Without pupil dilation; NIDEK AFC-230; modified Davis classification; 848x848px; 45-degree field of view:
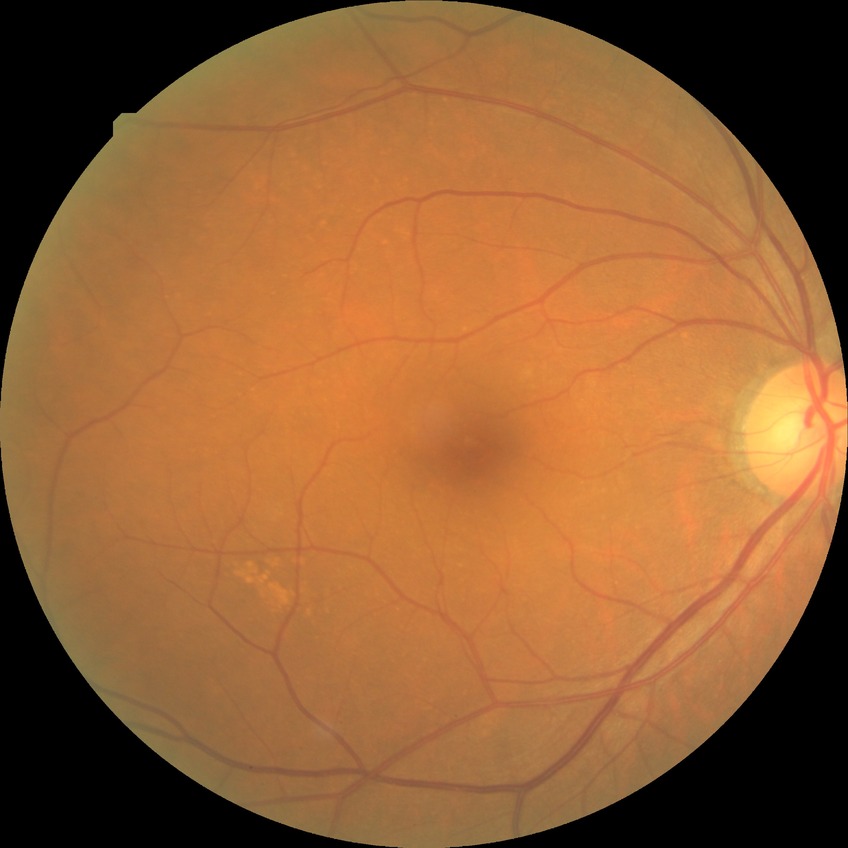

Retinopathy stage: no diabetic retinopathy.